Image size 2212x1659. 45° FOV. Retinal fundus photograph
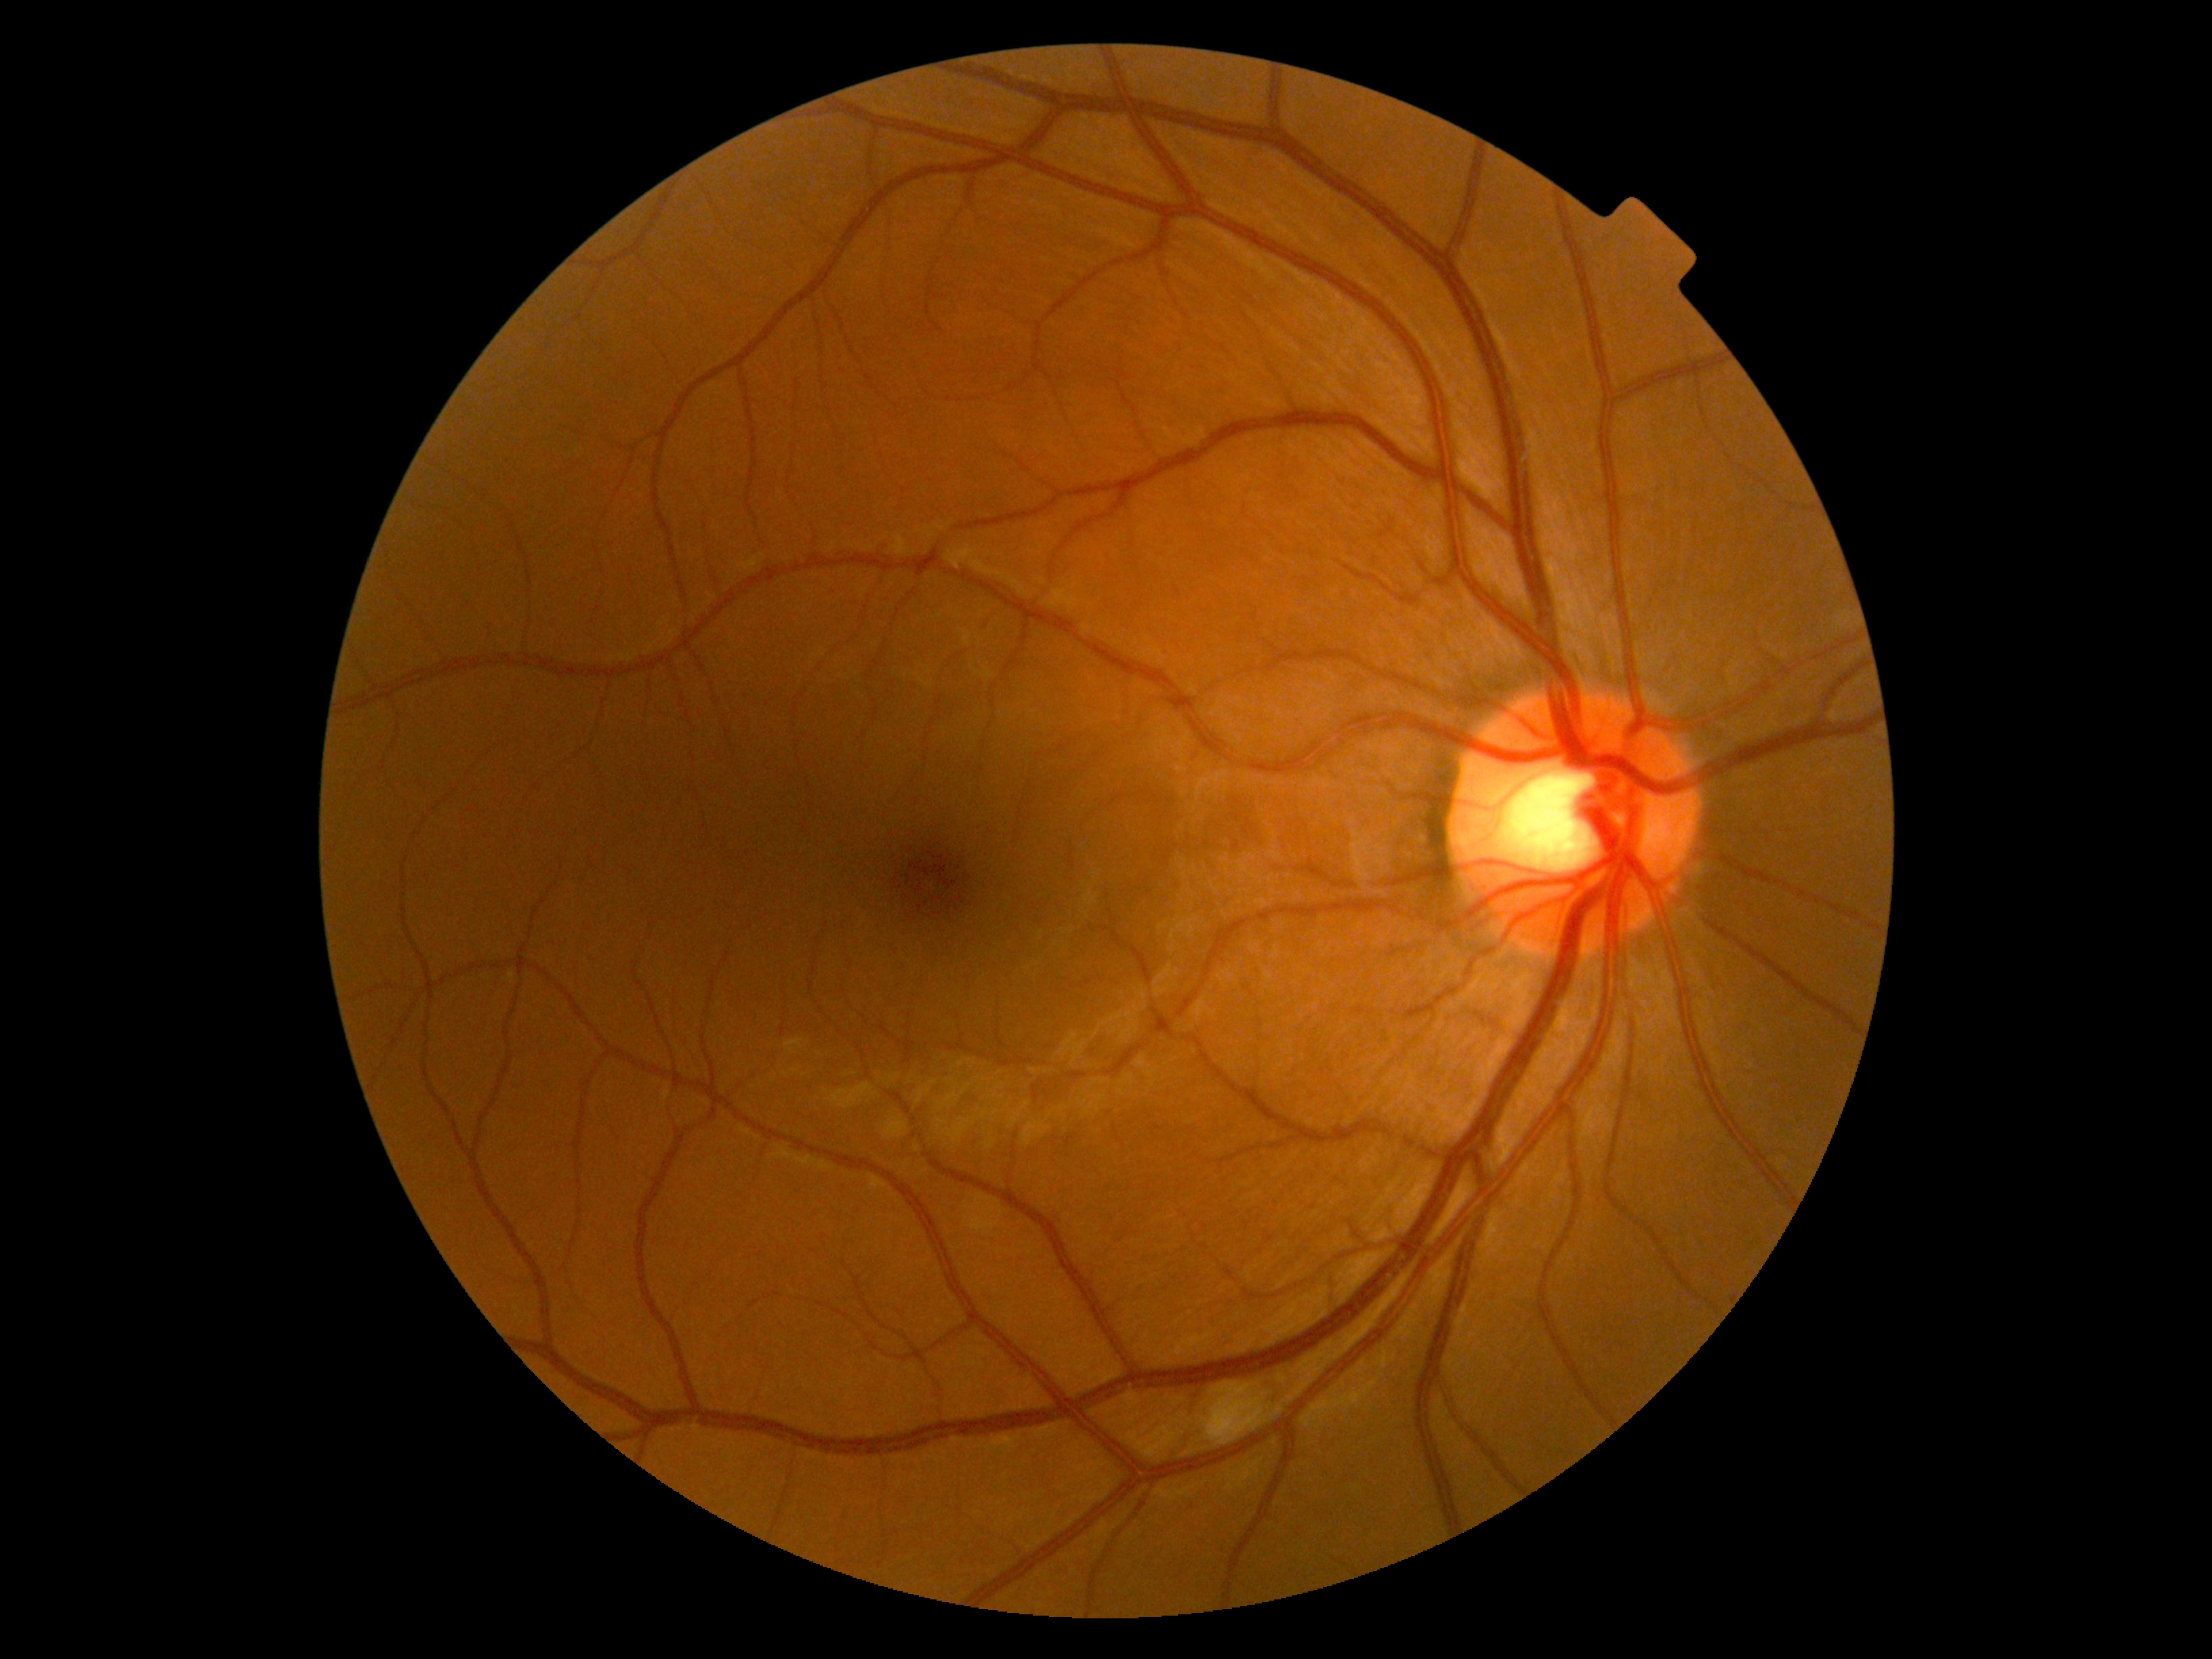

The retinopathy is classified as non-proliferative diabetic retinopathy.
DR: grade 2 — more than just microaneurysms but less than severe NPDR.